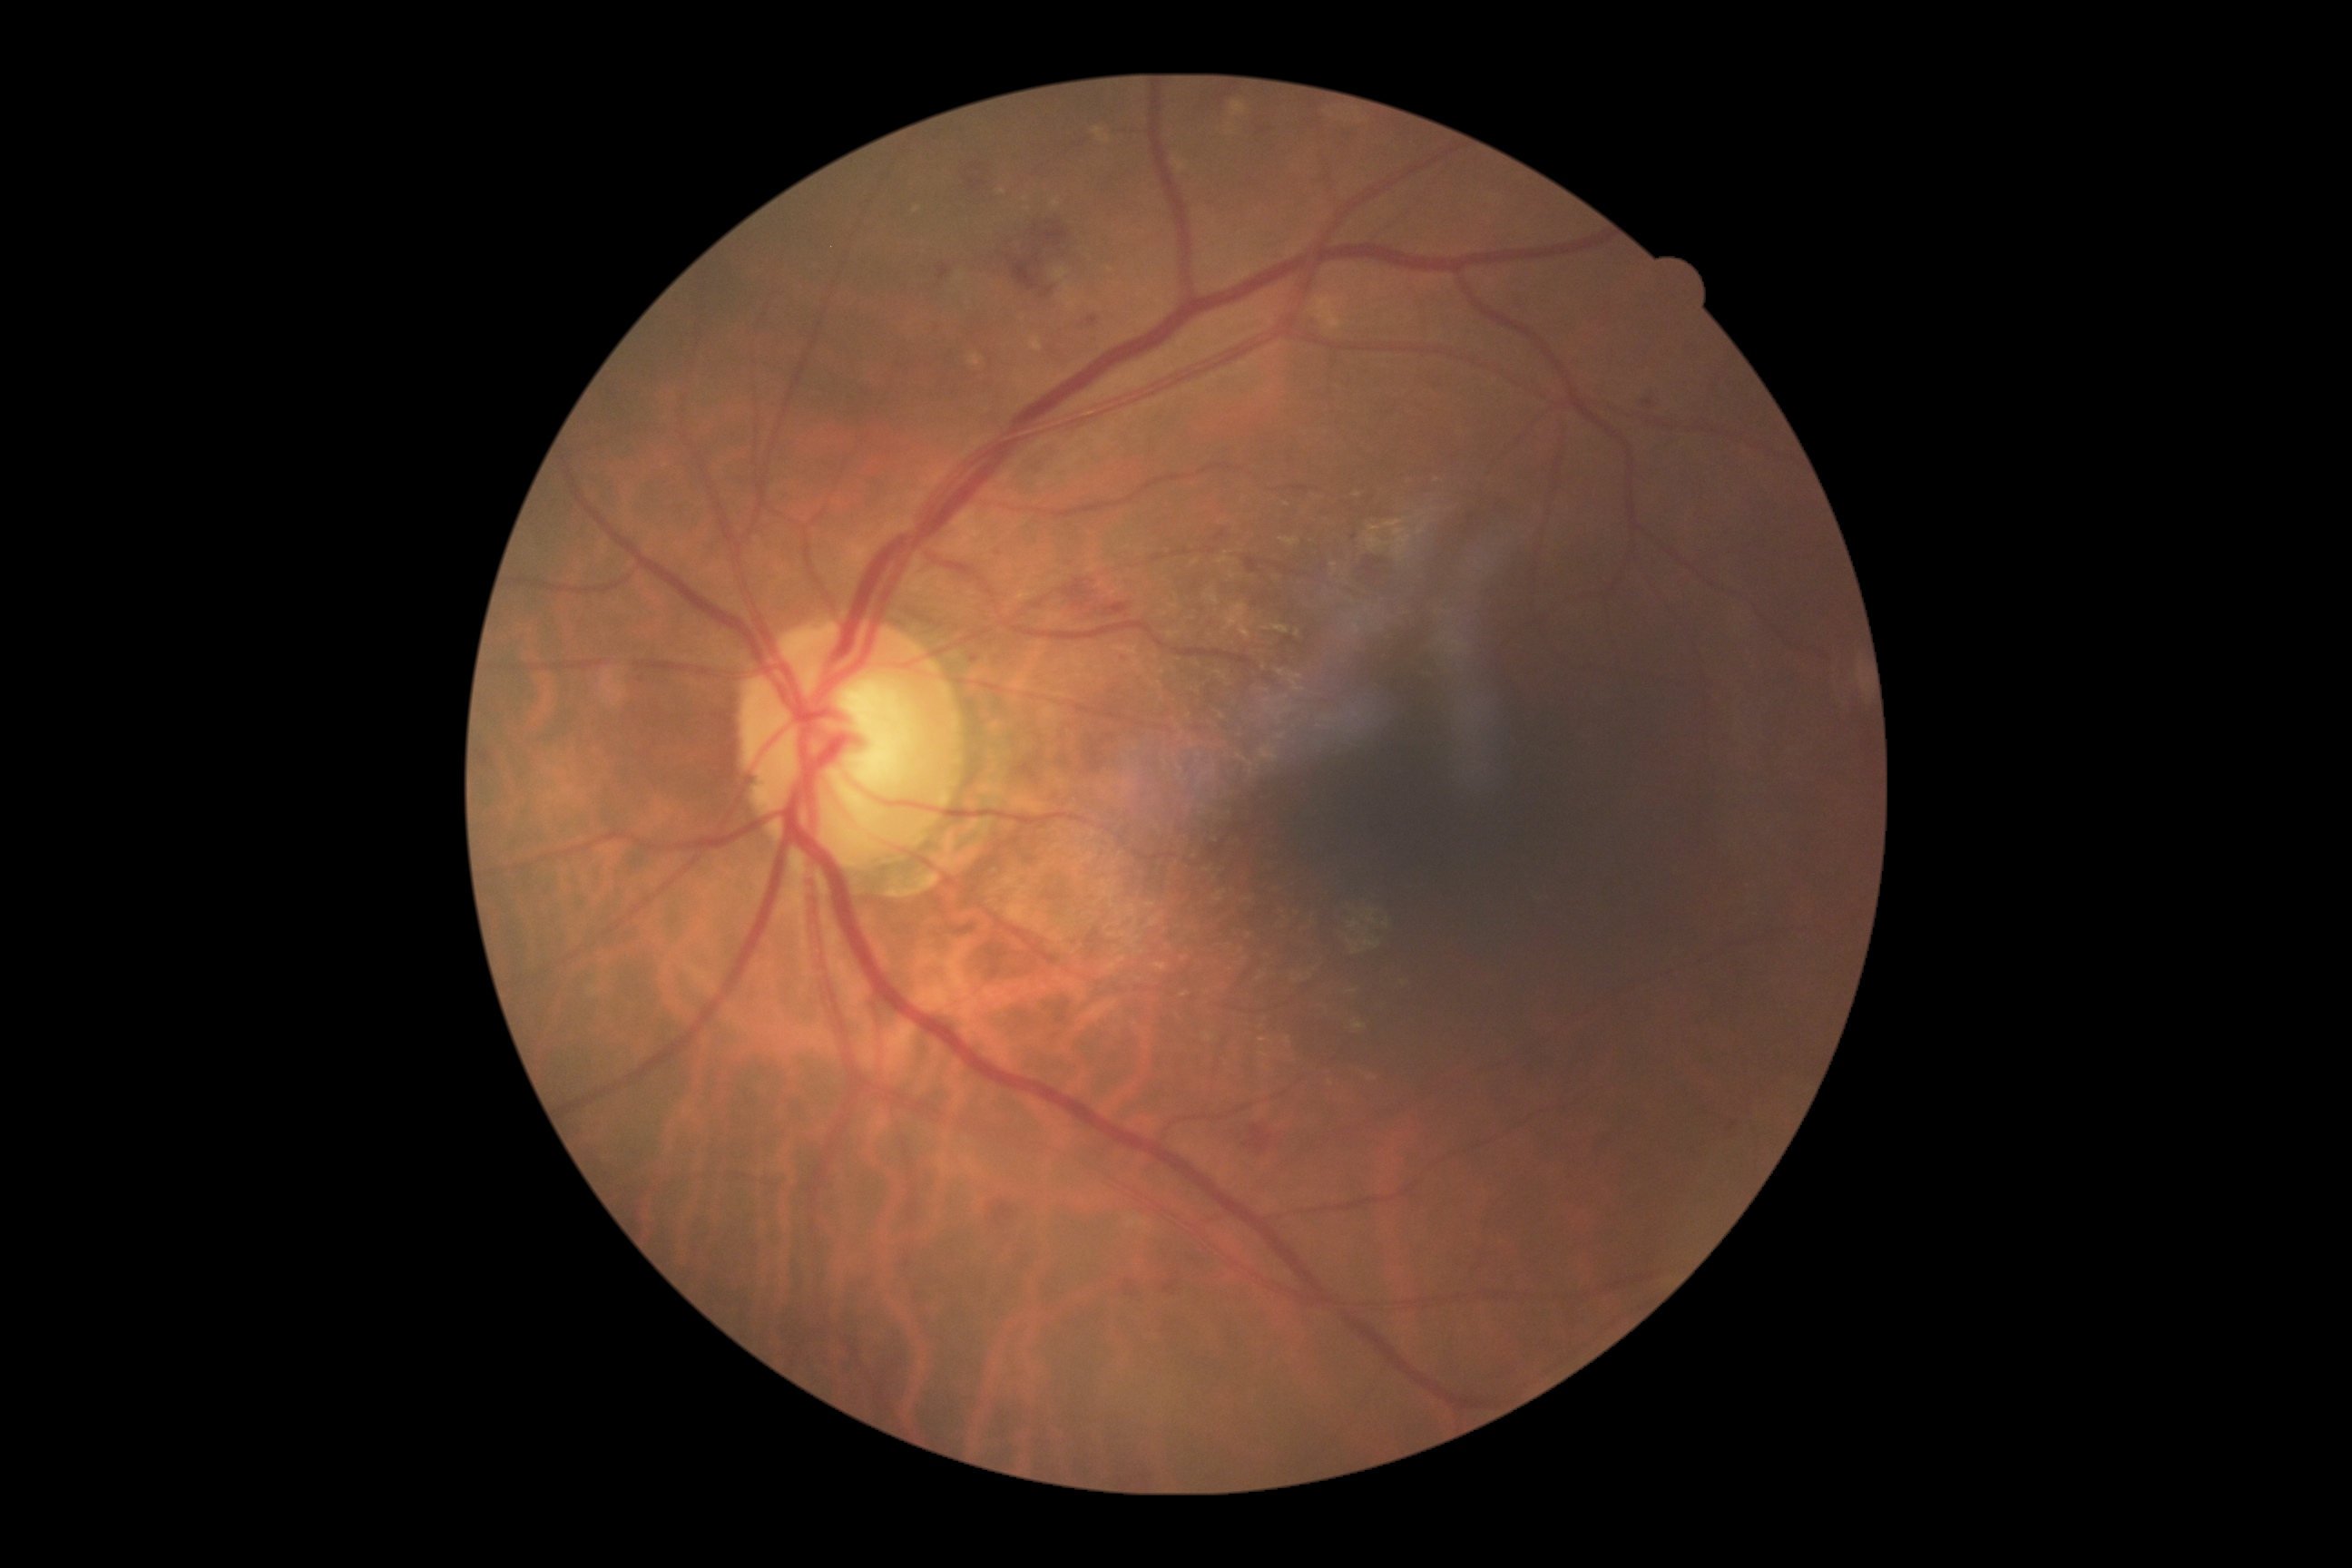
Diabetic retinopathy (DR): grade 2
Lesions identified (partial list):
hemorrhages (HEs) (subset): region(1220, 93, 1231, 99), region(1019, 760, 1041, 779), region(1244, 1126, 1273, 1155), region(937, 264, 952, 280), region(1259, 128, 1271, 135), region(1063, 578, 1097, 612), region(1088, 315, 1099, 328), region(1086, 603, 1132, 620), region(1162, 1280, 1177, 1293), region(1729, 1121, 1738, 1132)
hard exudates (EXs) (subset): region(1416, 529, 1427, 536), region(1273, 625, 1289, 634), region(1173, 159, 1190, 172), region(1280, 538, 1300, 547), region(1231, 101, 1248, 117), region(1093, 128, 1112, 144), region(1369, 525, 1380, 533), region(970, 357, 981, 368), region(1315, 297, 1342, 329)
EXs (small, approximate centers) near (917, 210), (1056, 204), (1435, 511), (1426, 524)